Axial length 23.68 mm; IOP (pneumatic tonometry): 10 mmHg; refractive error: sphere +1.75 D, cylinder -1.5 D, axis 73°
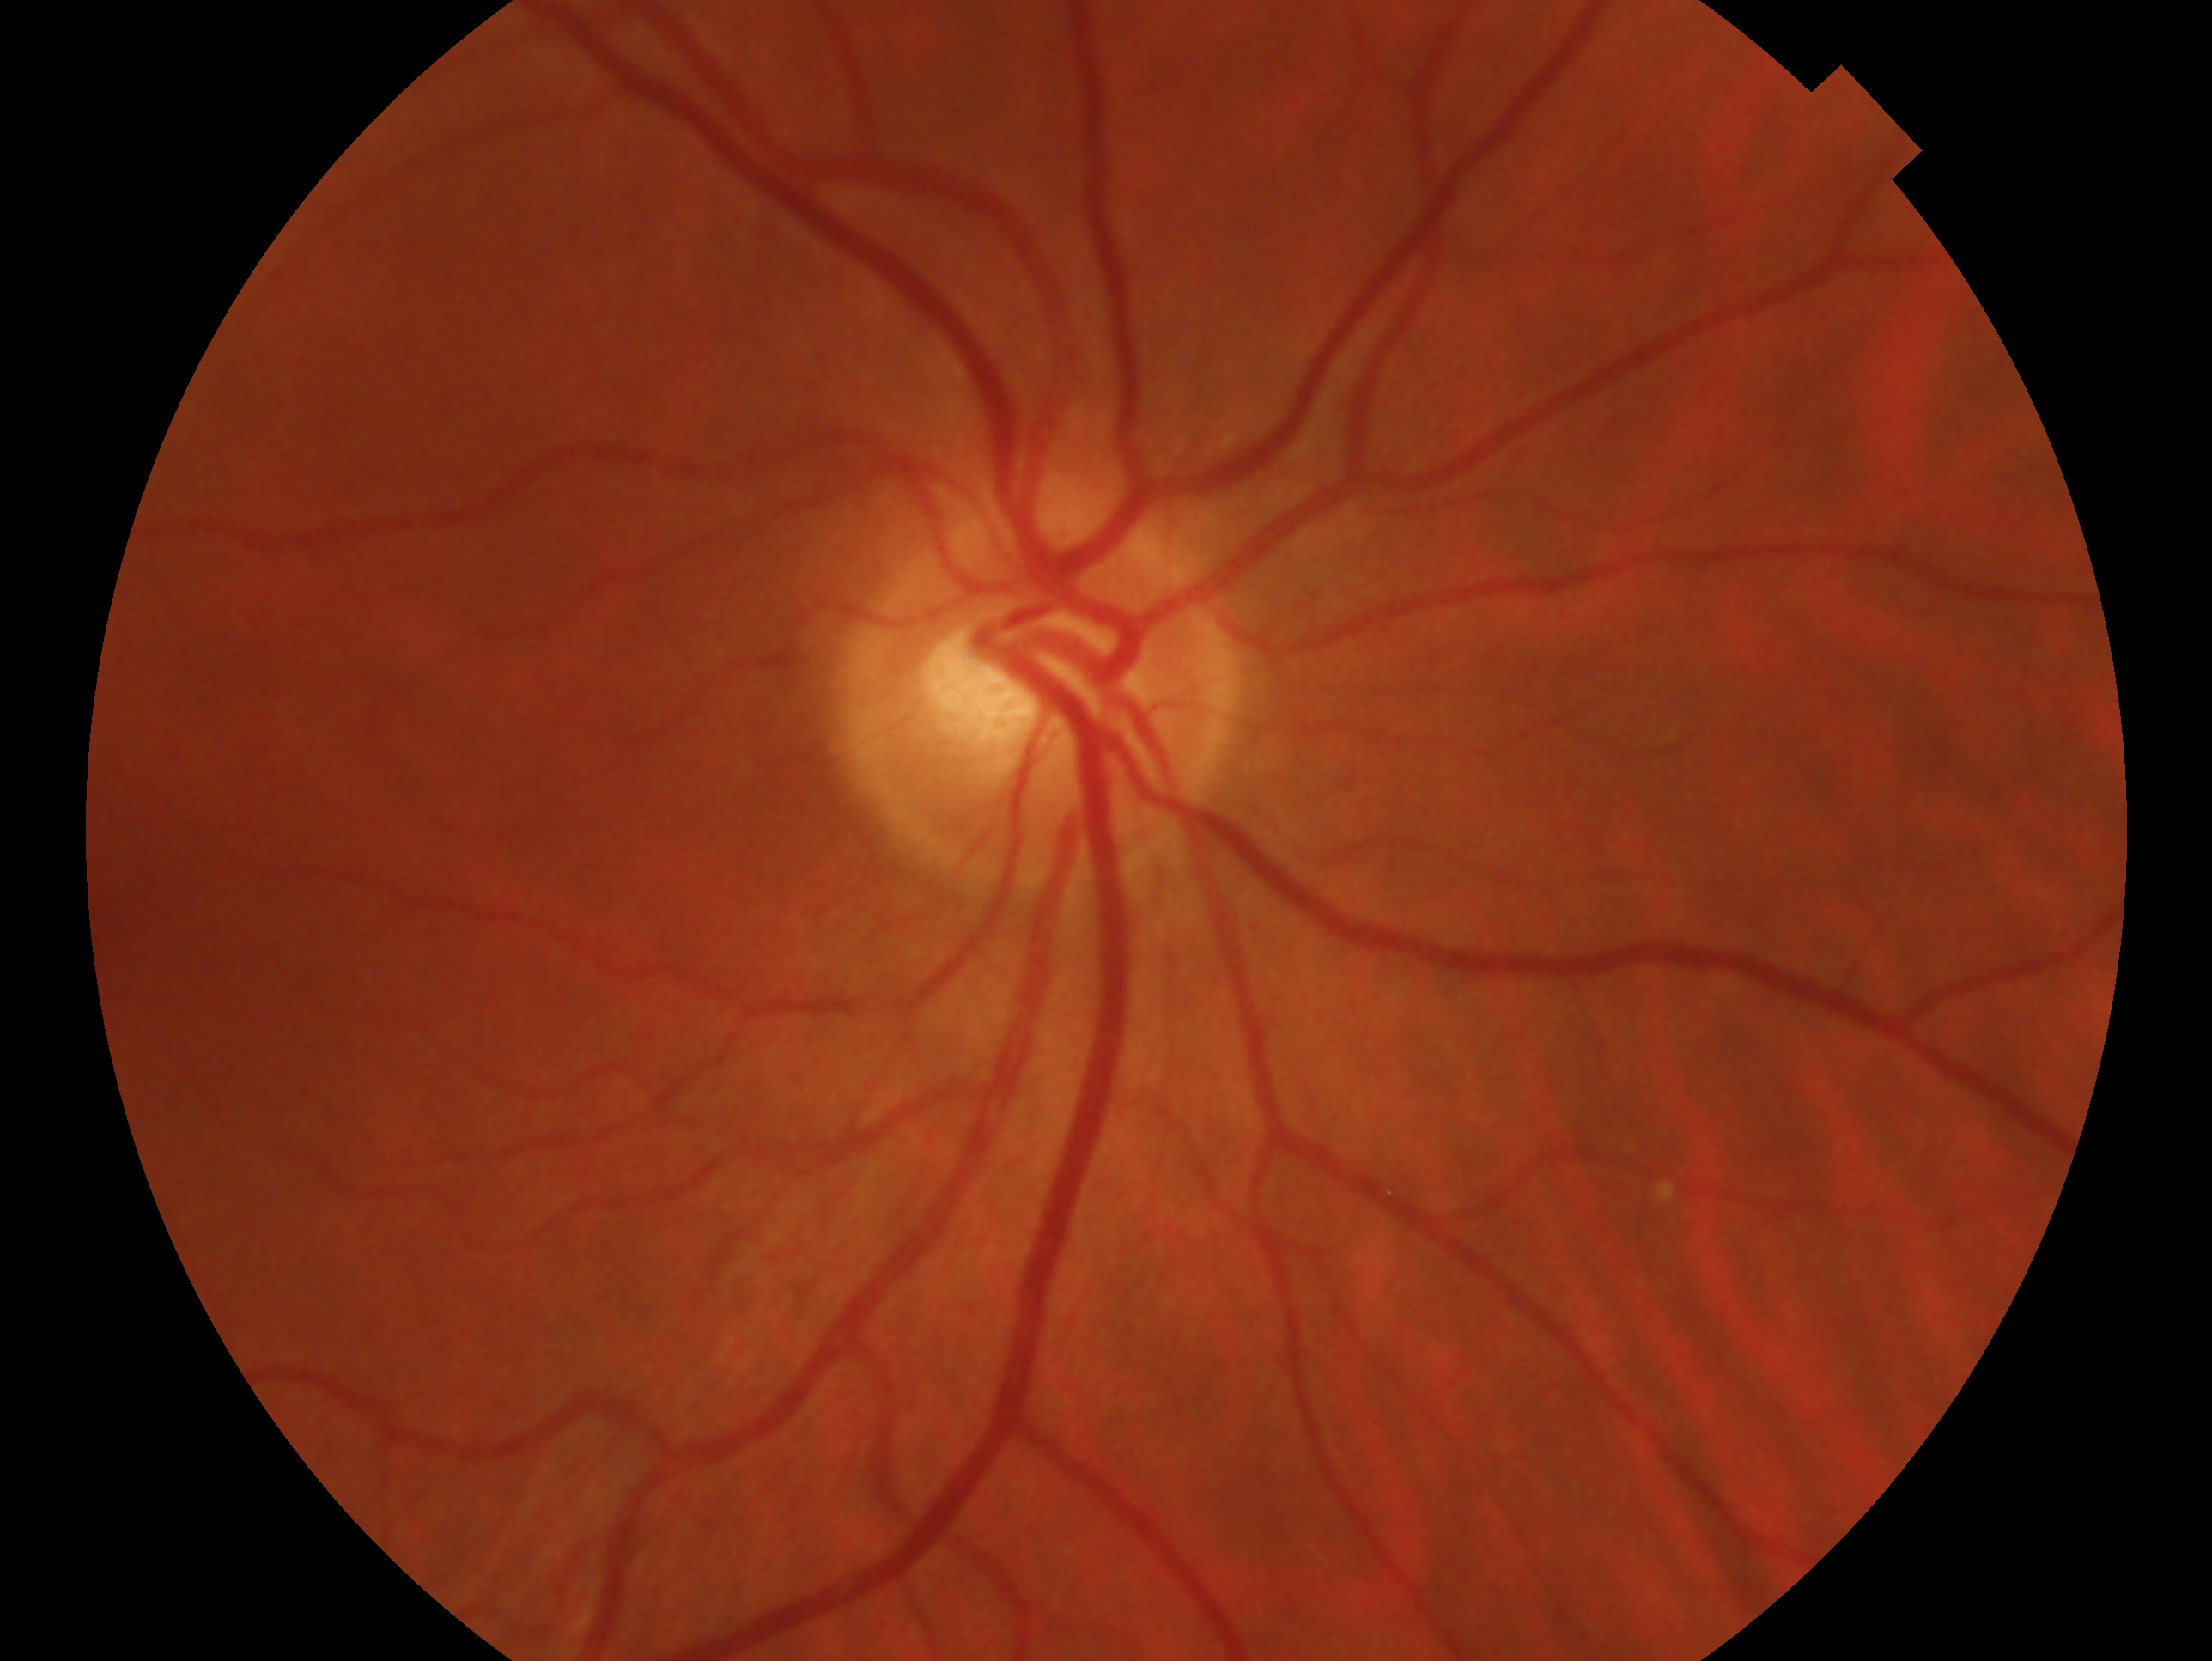 The image shows the oculus dexter.
Diagnosis: no glaucoma.